Image size 848x848; modified Davis grading; posterior pole color fundus photograph
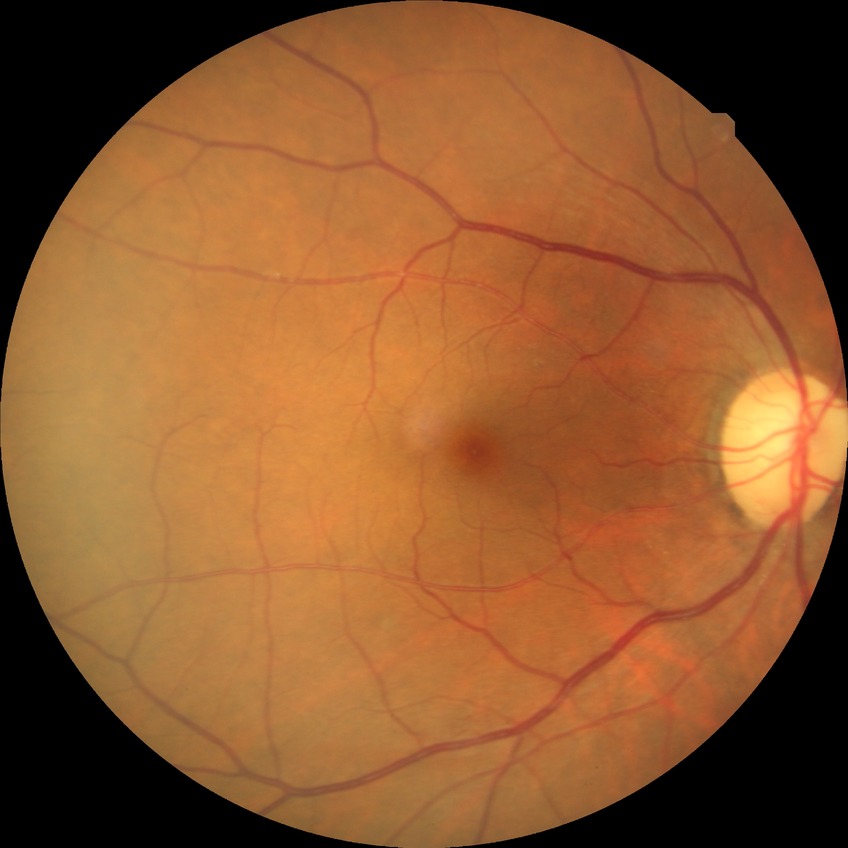 Diabetic retinopathy grade: no diabetic retinopathy.